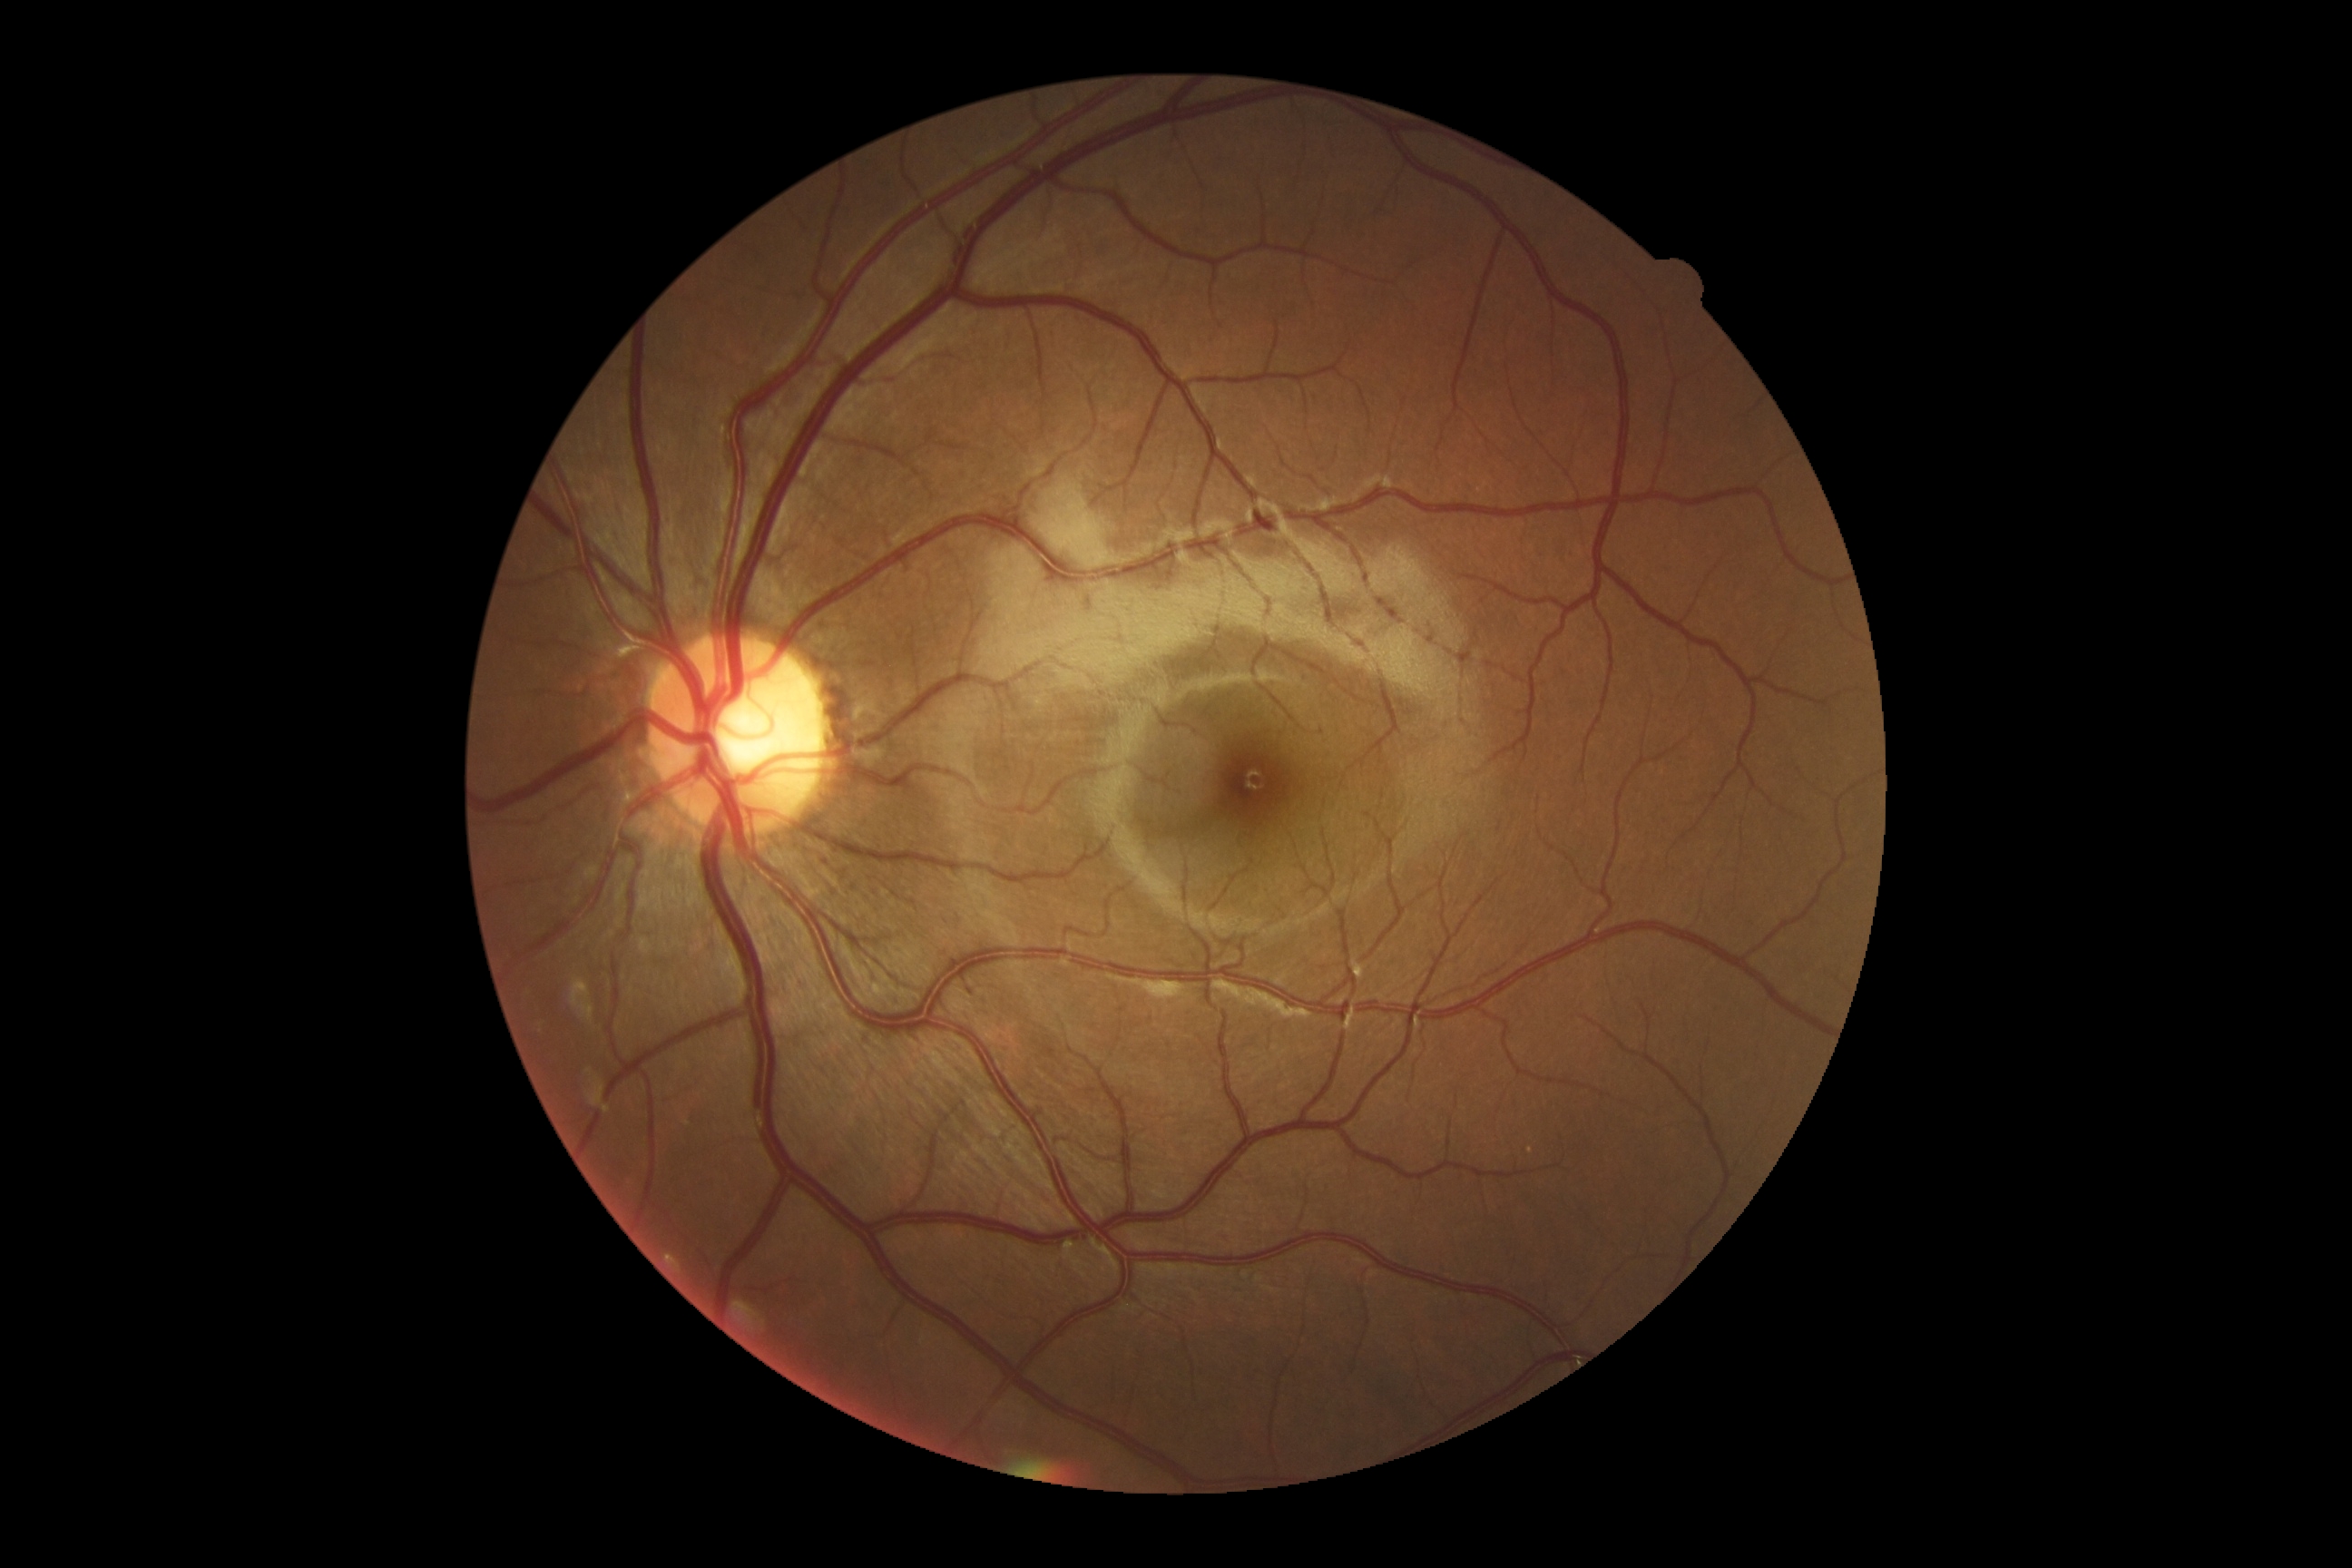
diabetic retinopathy: no apparent retinopathy (grade 0) — no visible signs of diabetic retinopathy.